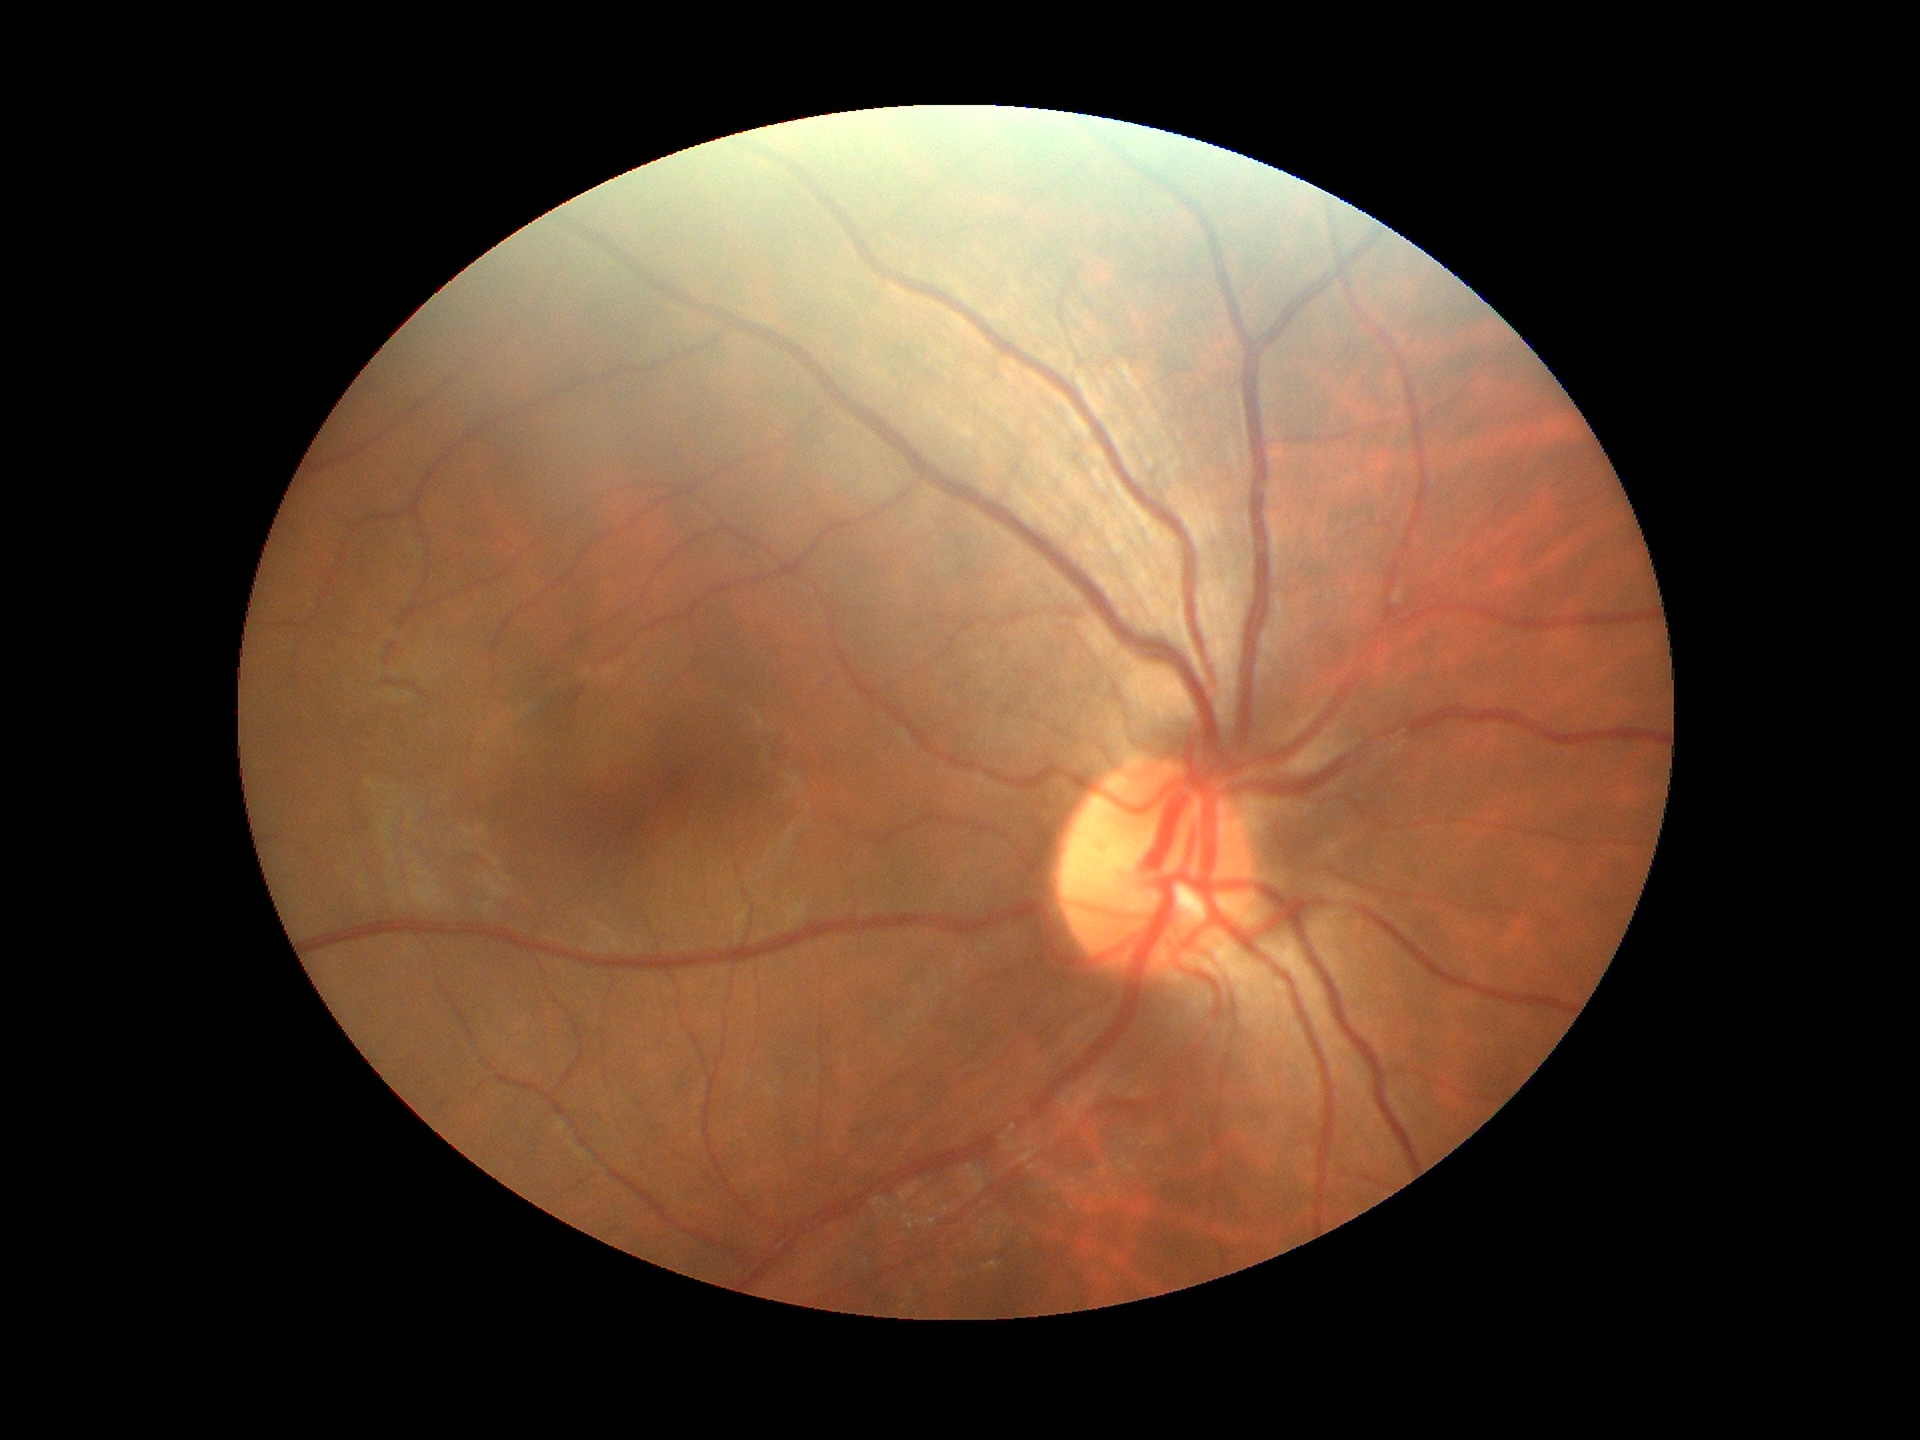

Annotations:
• Glaucoma screening · no suspicious findings
• vertical cup-disc ratio (VCDR) · 0.41